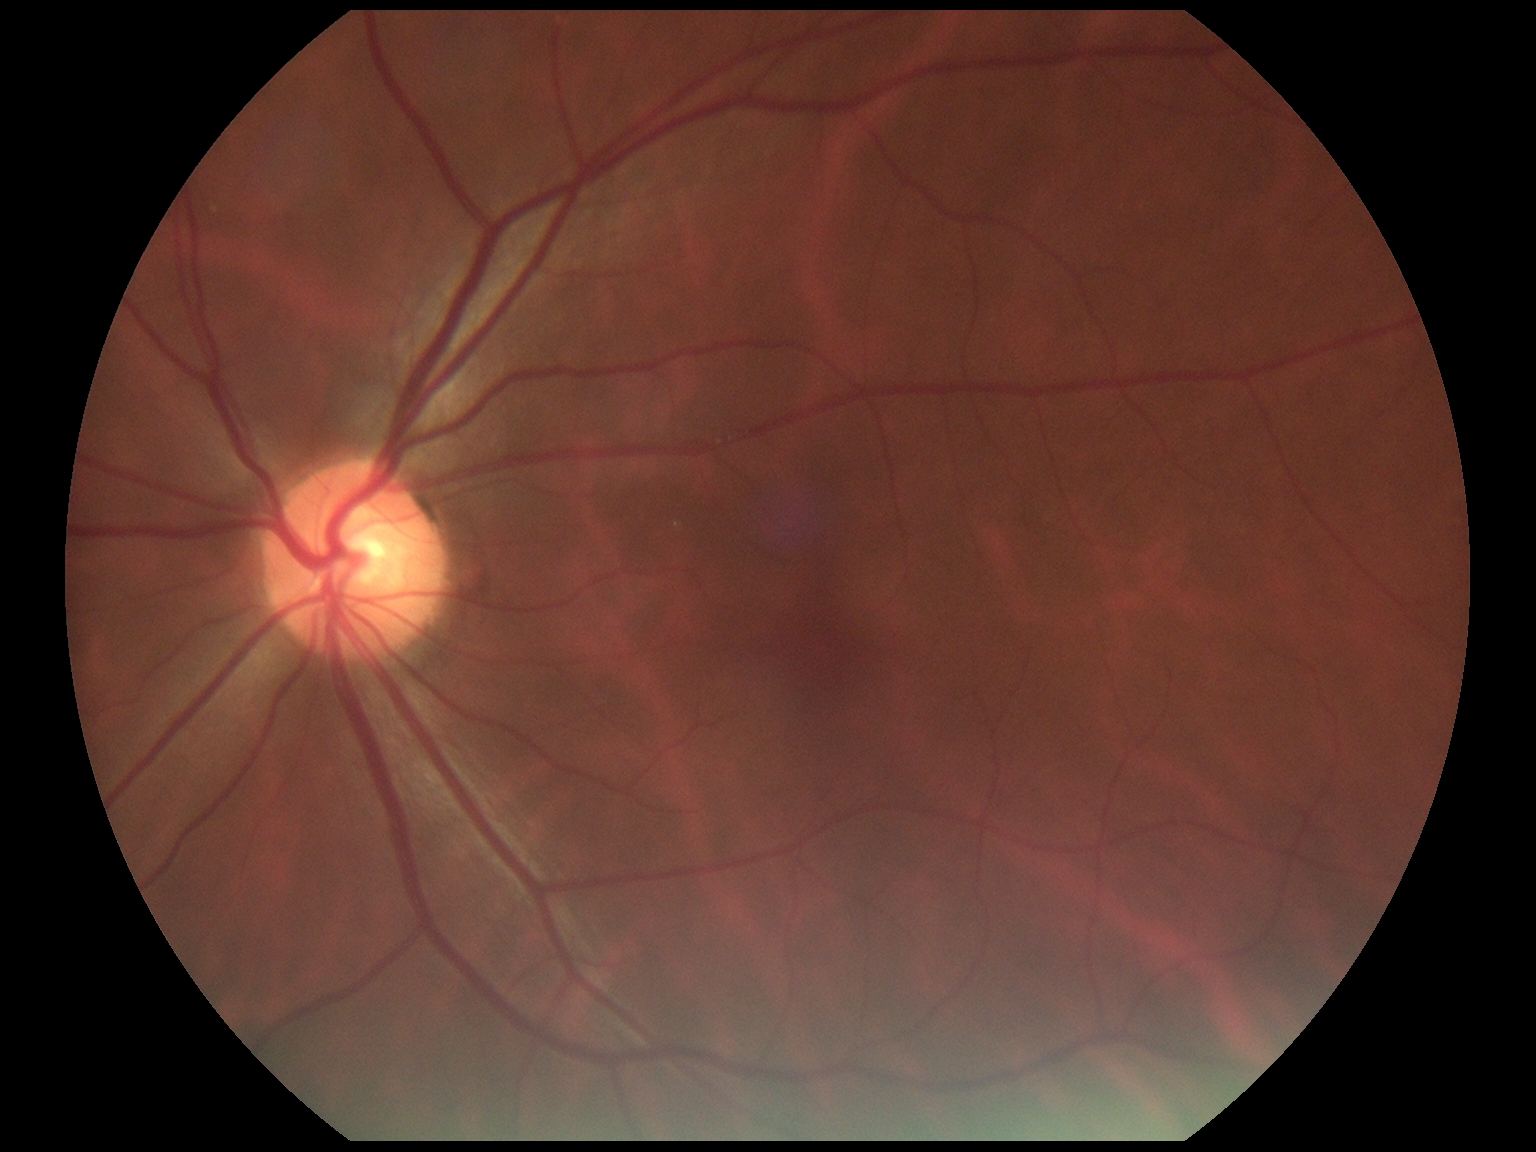 diabetic retinopathy (DR) = grade 0 (no apparent retinopathy).